1960x1897. 45° field of view:
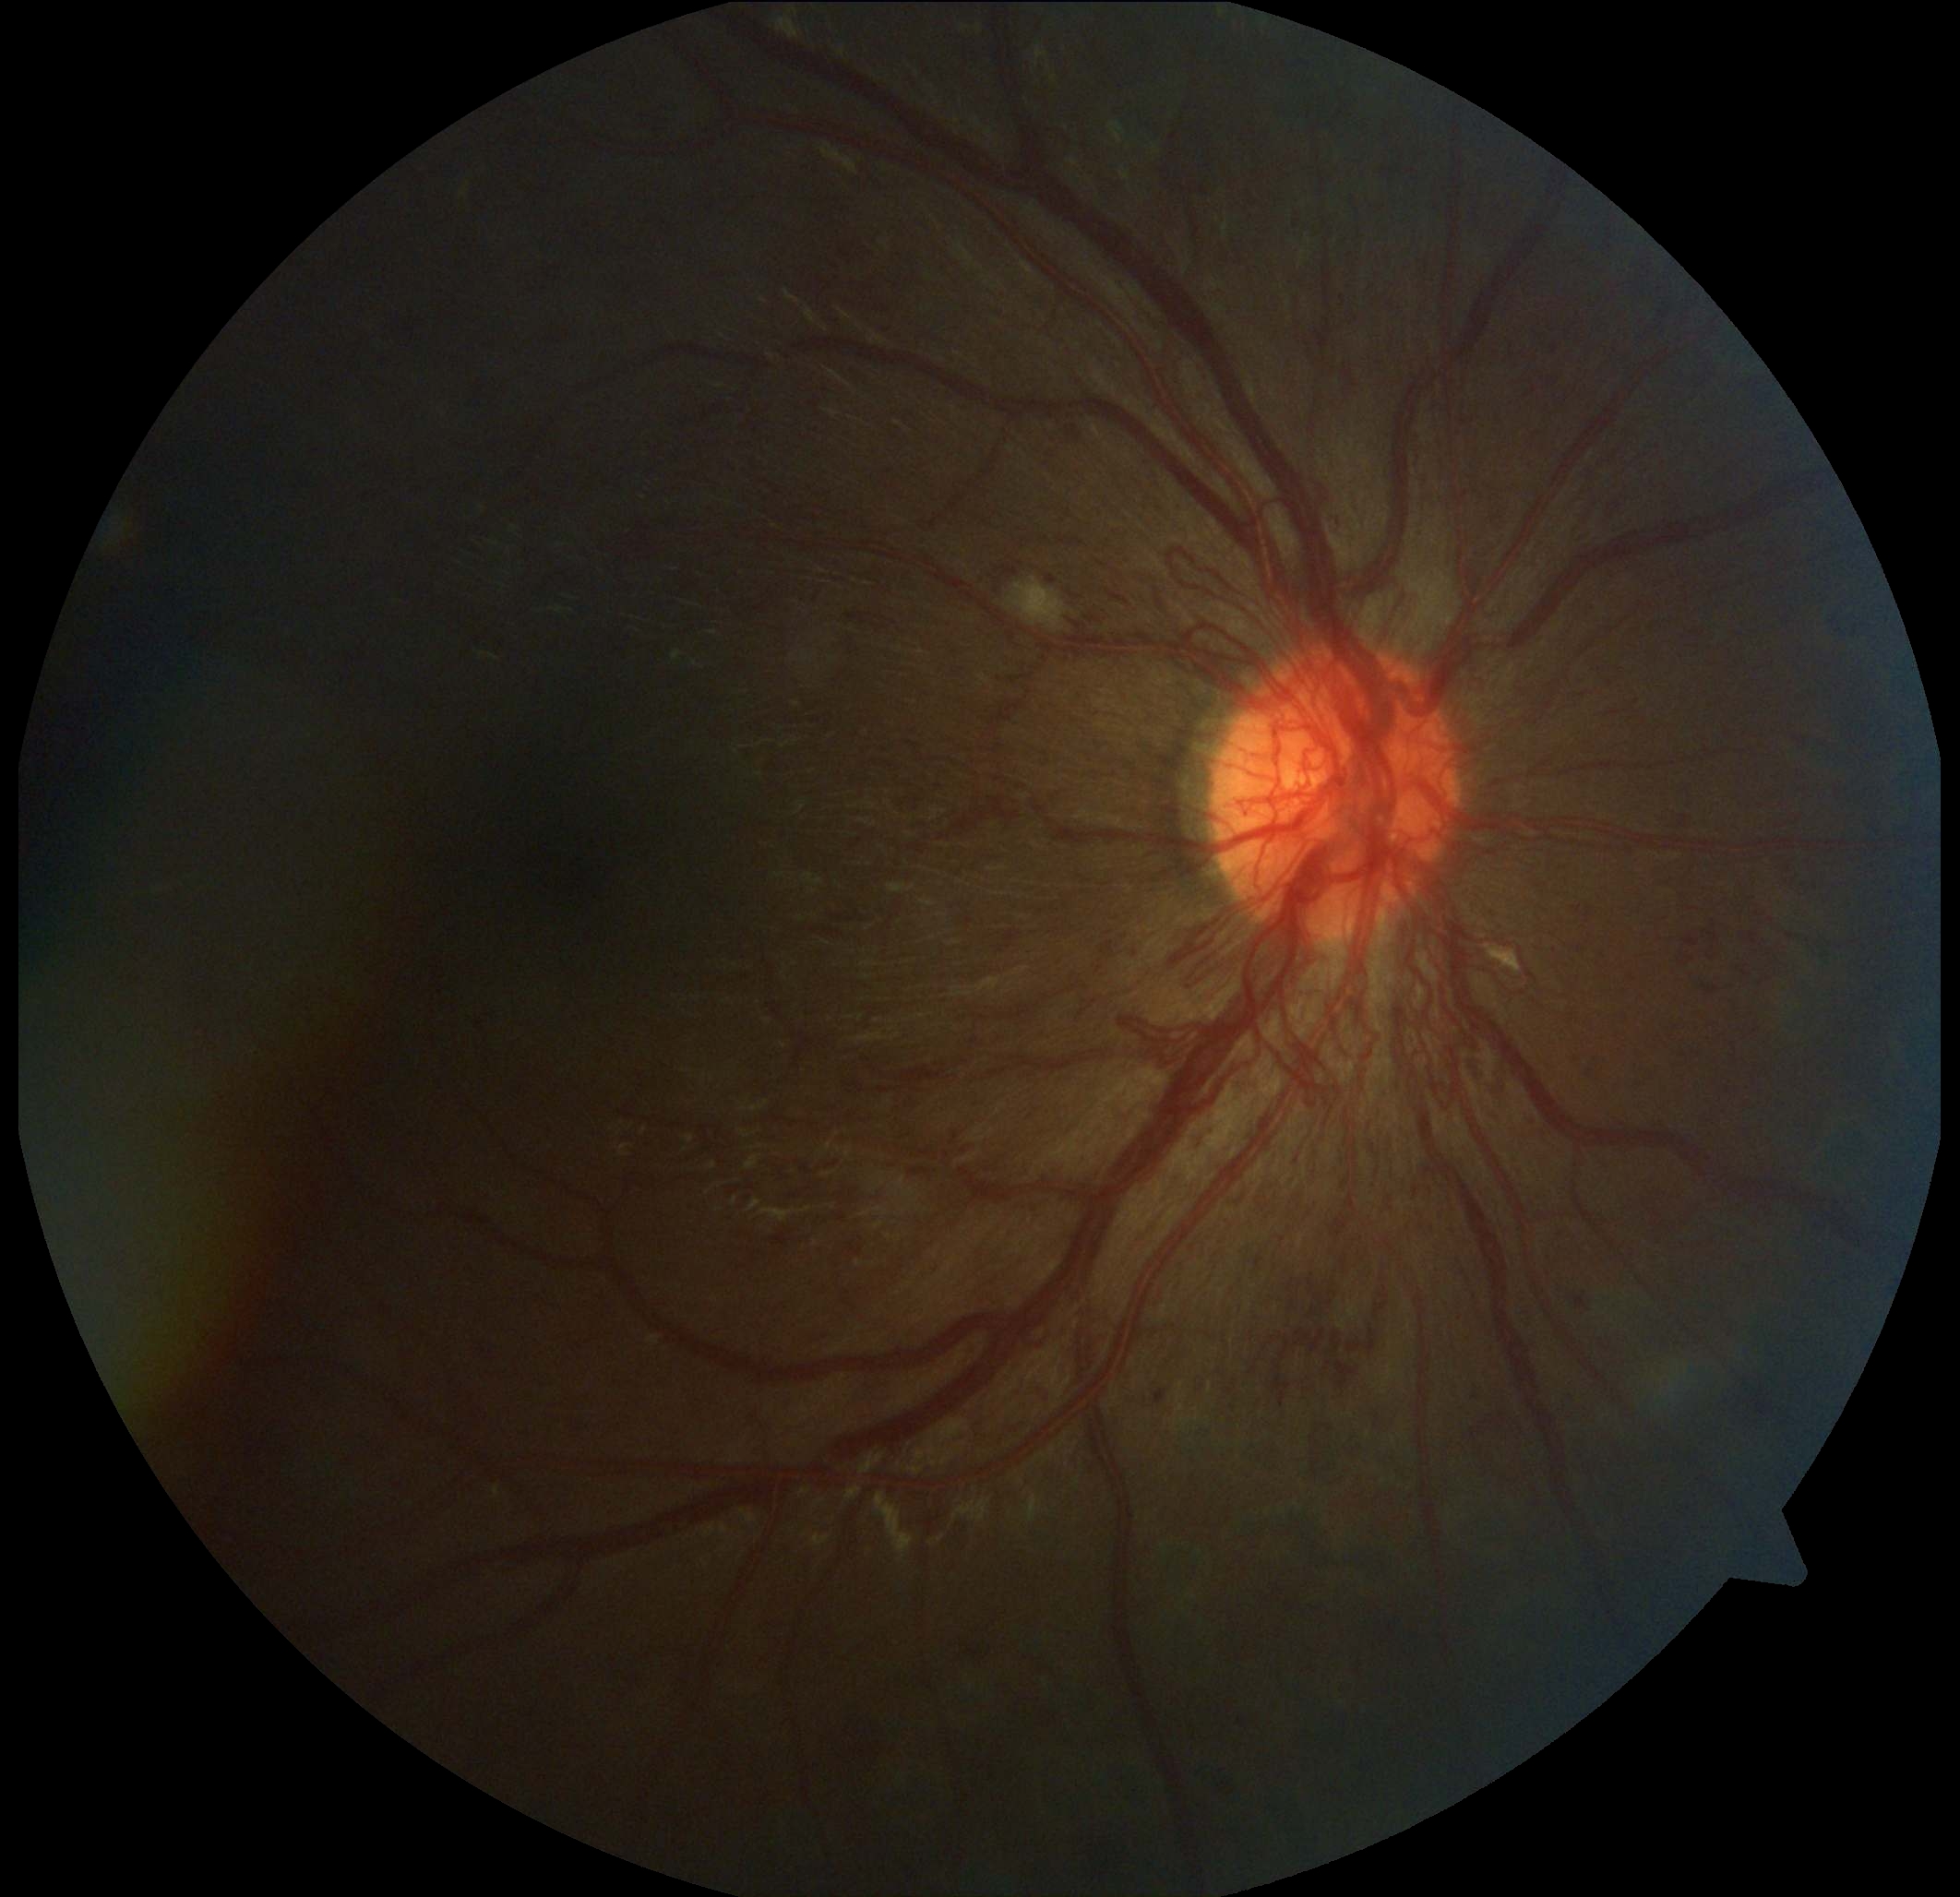

The retinopathy is classified as proliferative diabetic retinopathy. DR stage is 4.